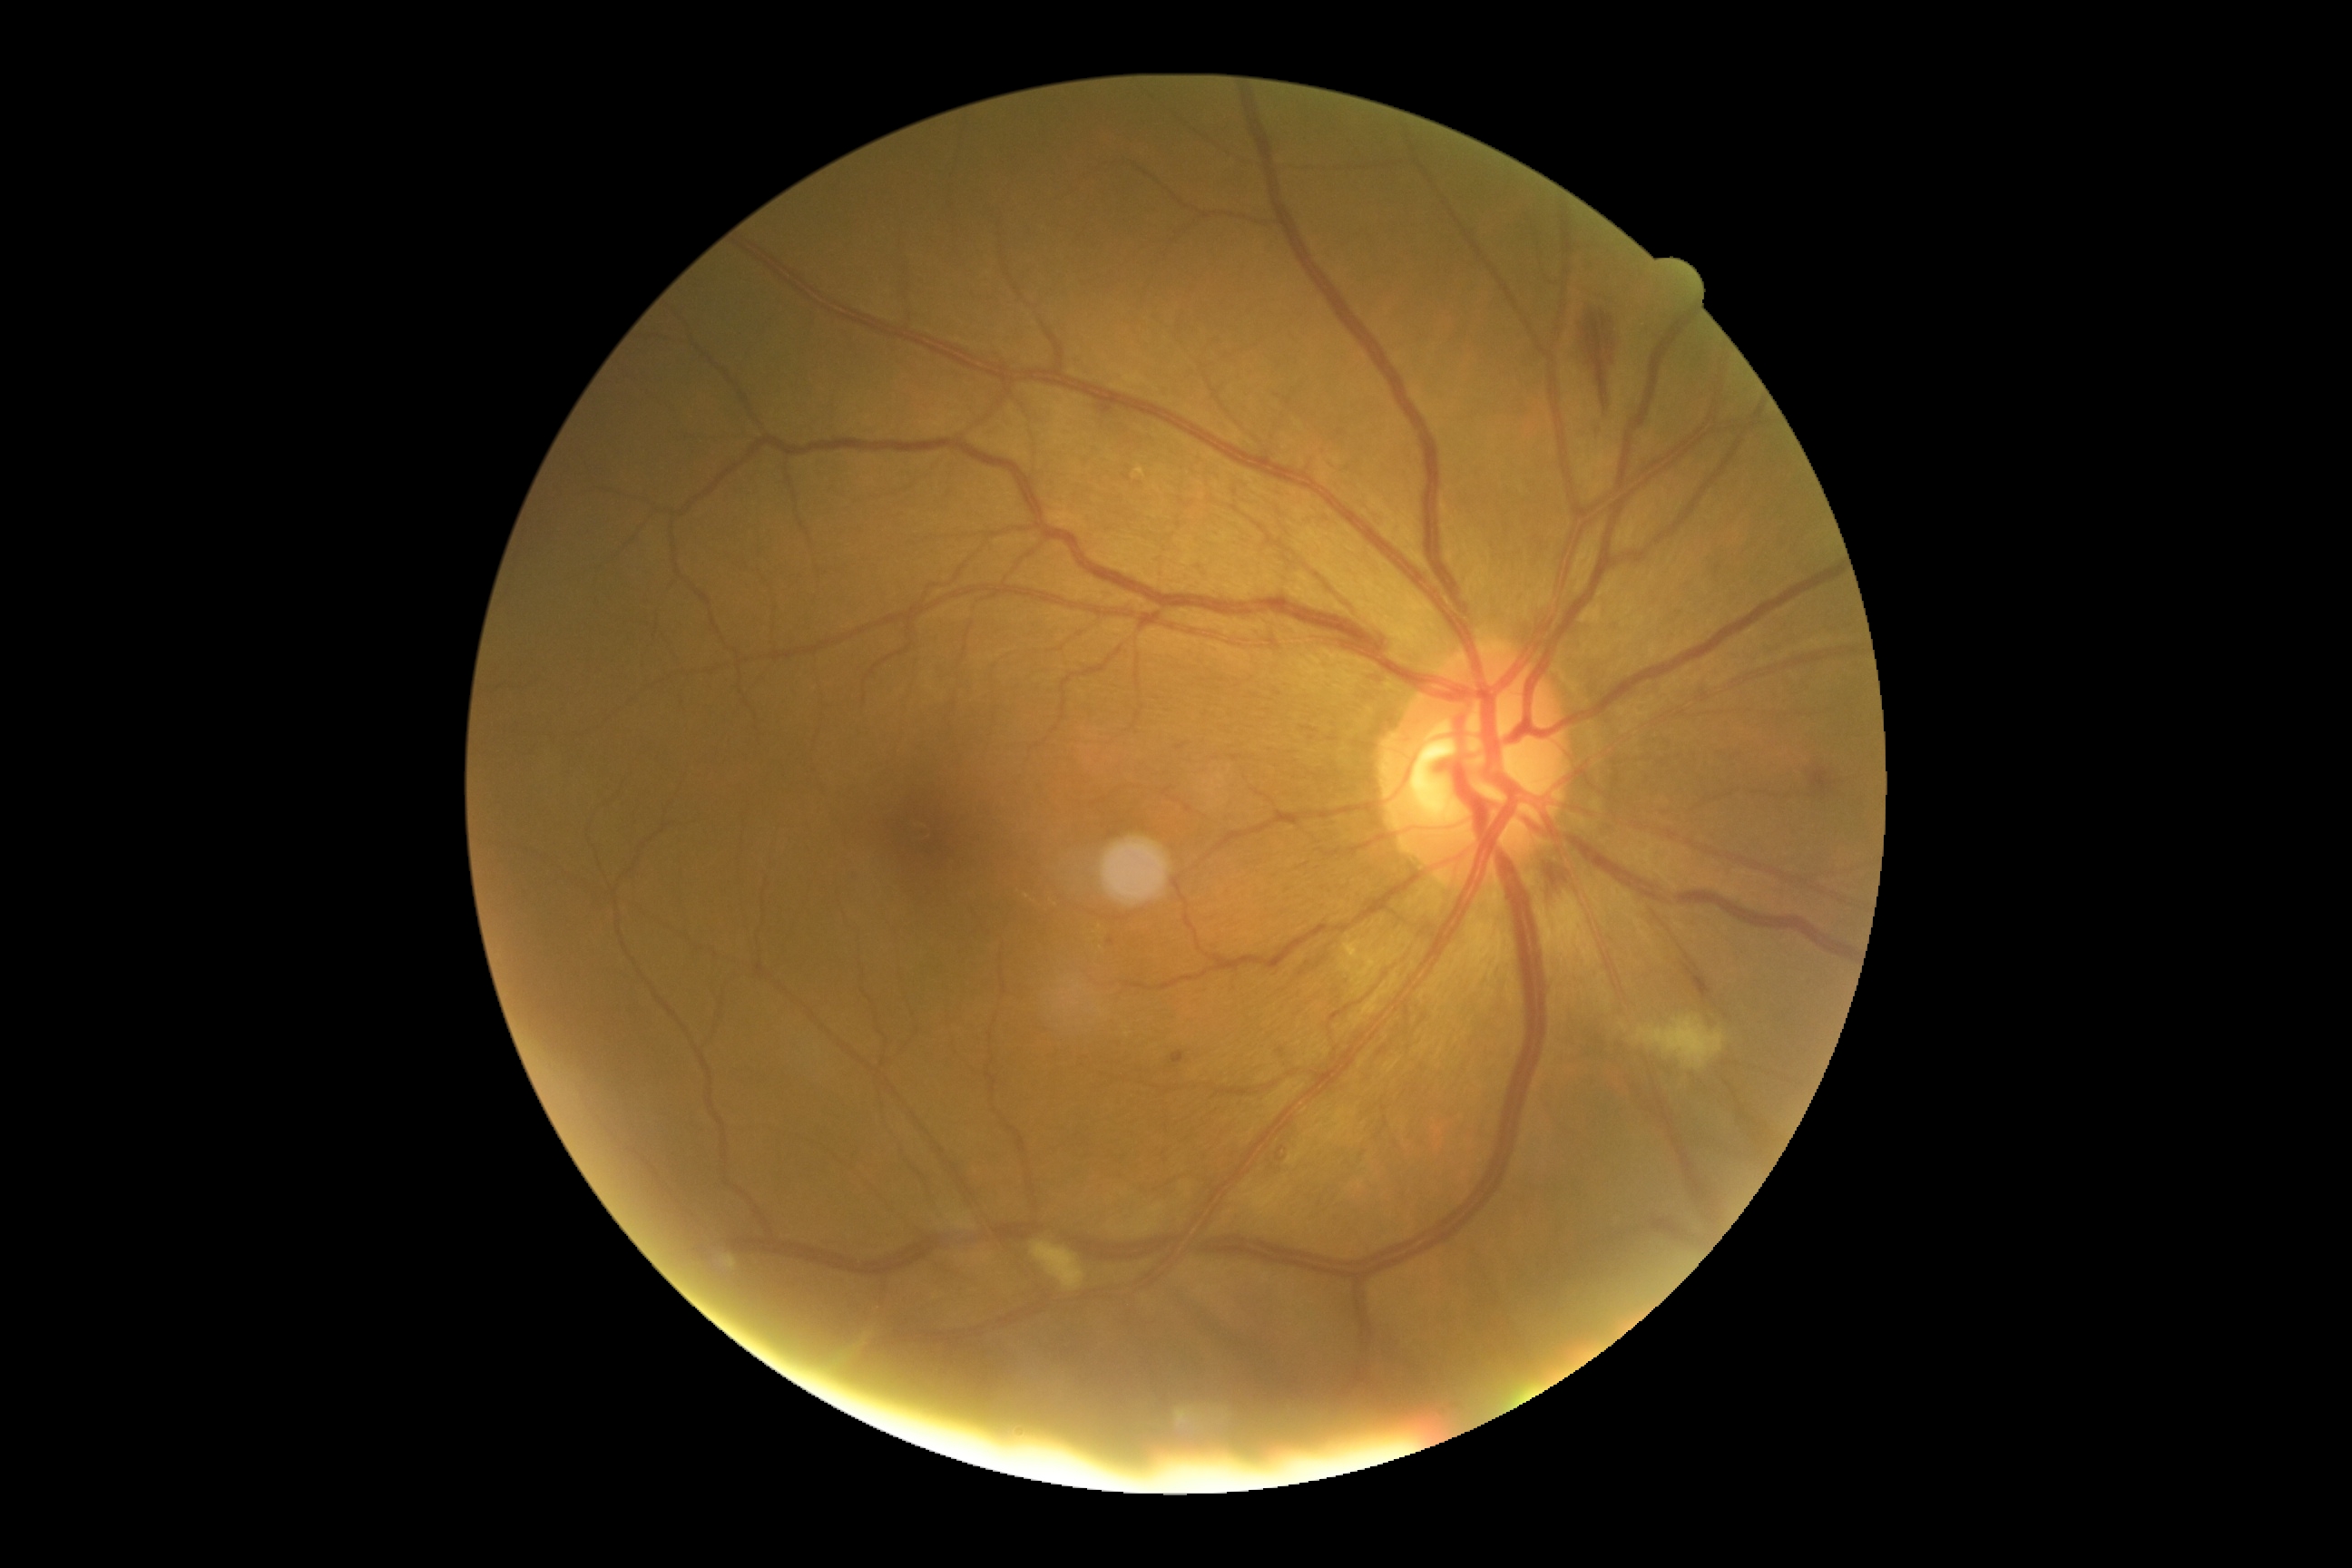 DR severity: 2/4.